Fundus photo
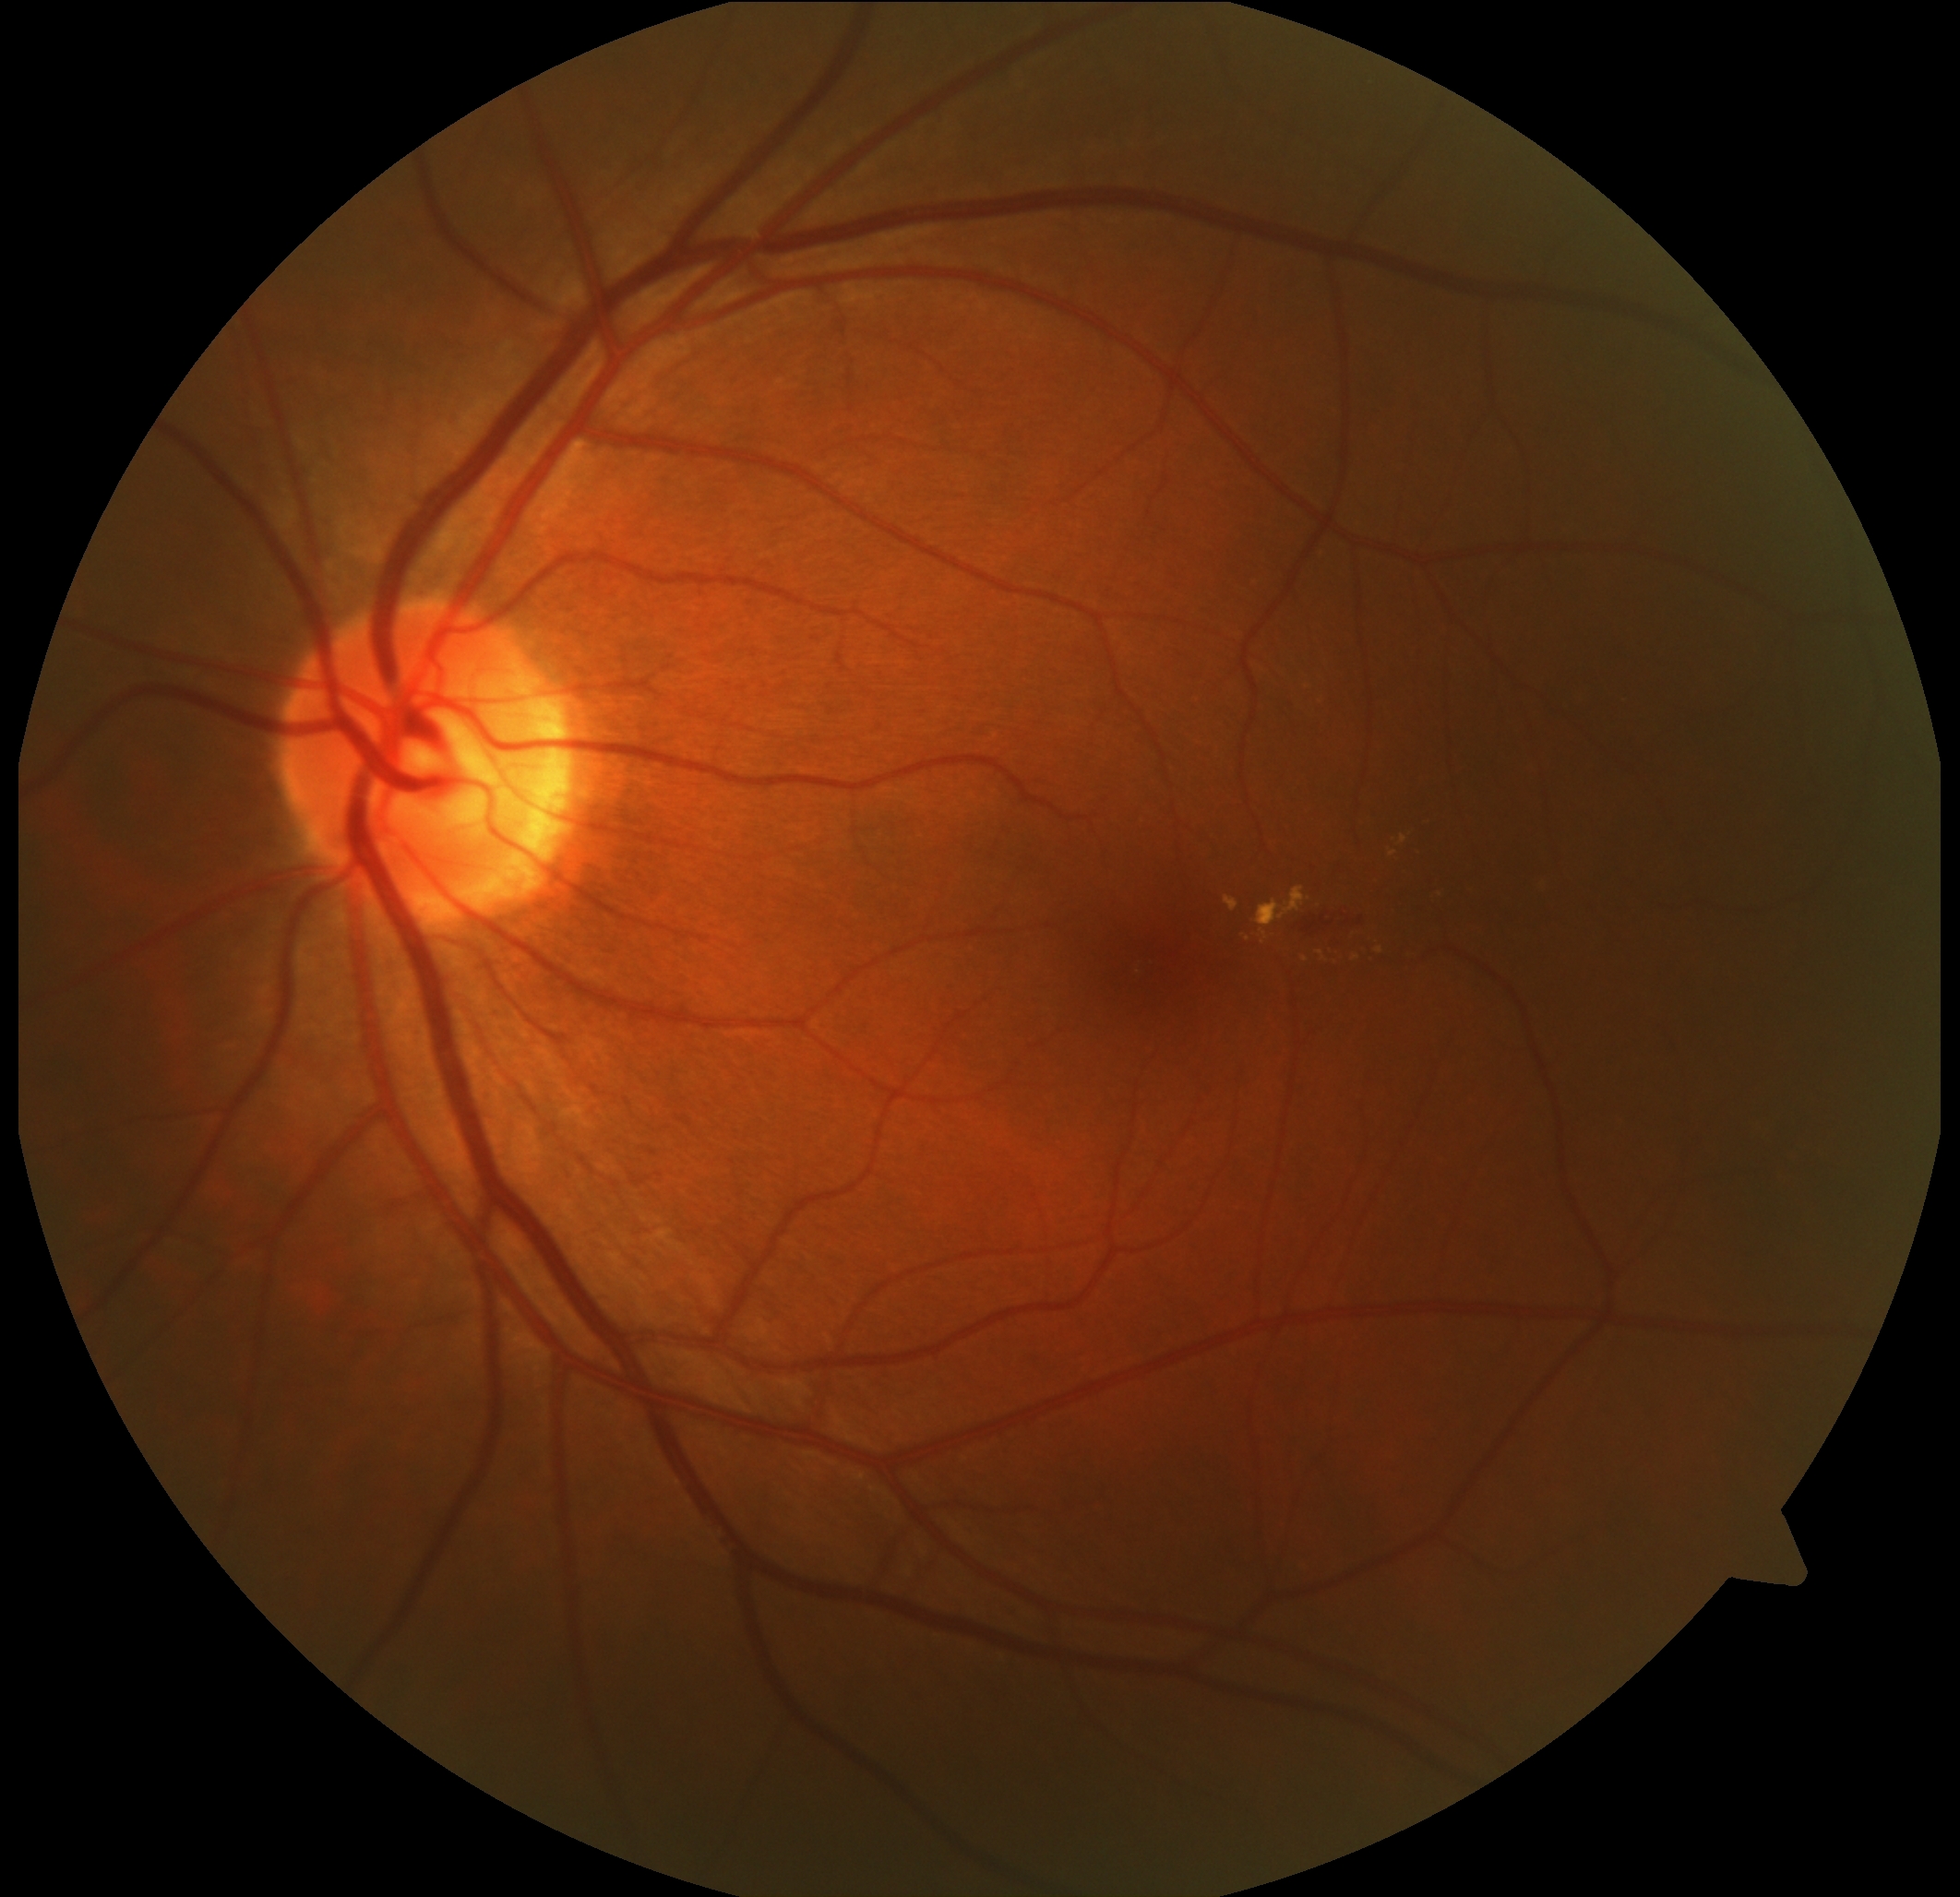

Diabetic retinopathy (DR): moderate non-proliferative diabetic retinopathy (grade 2).